45° FOV — 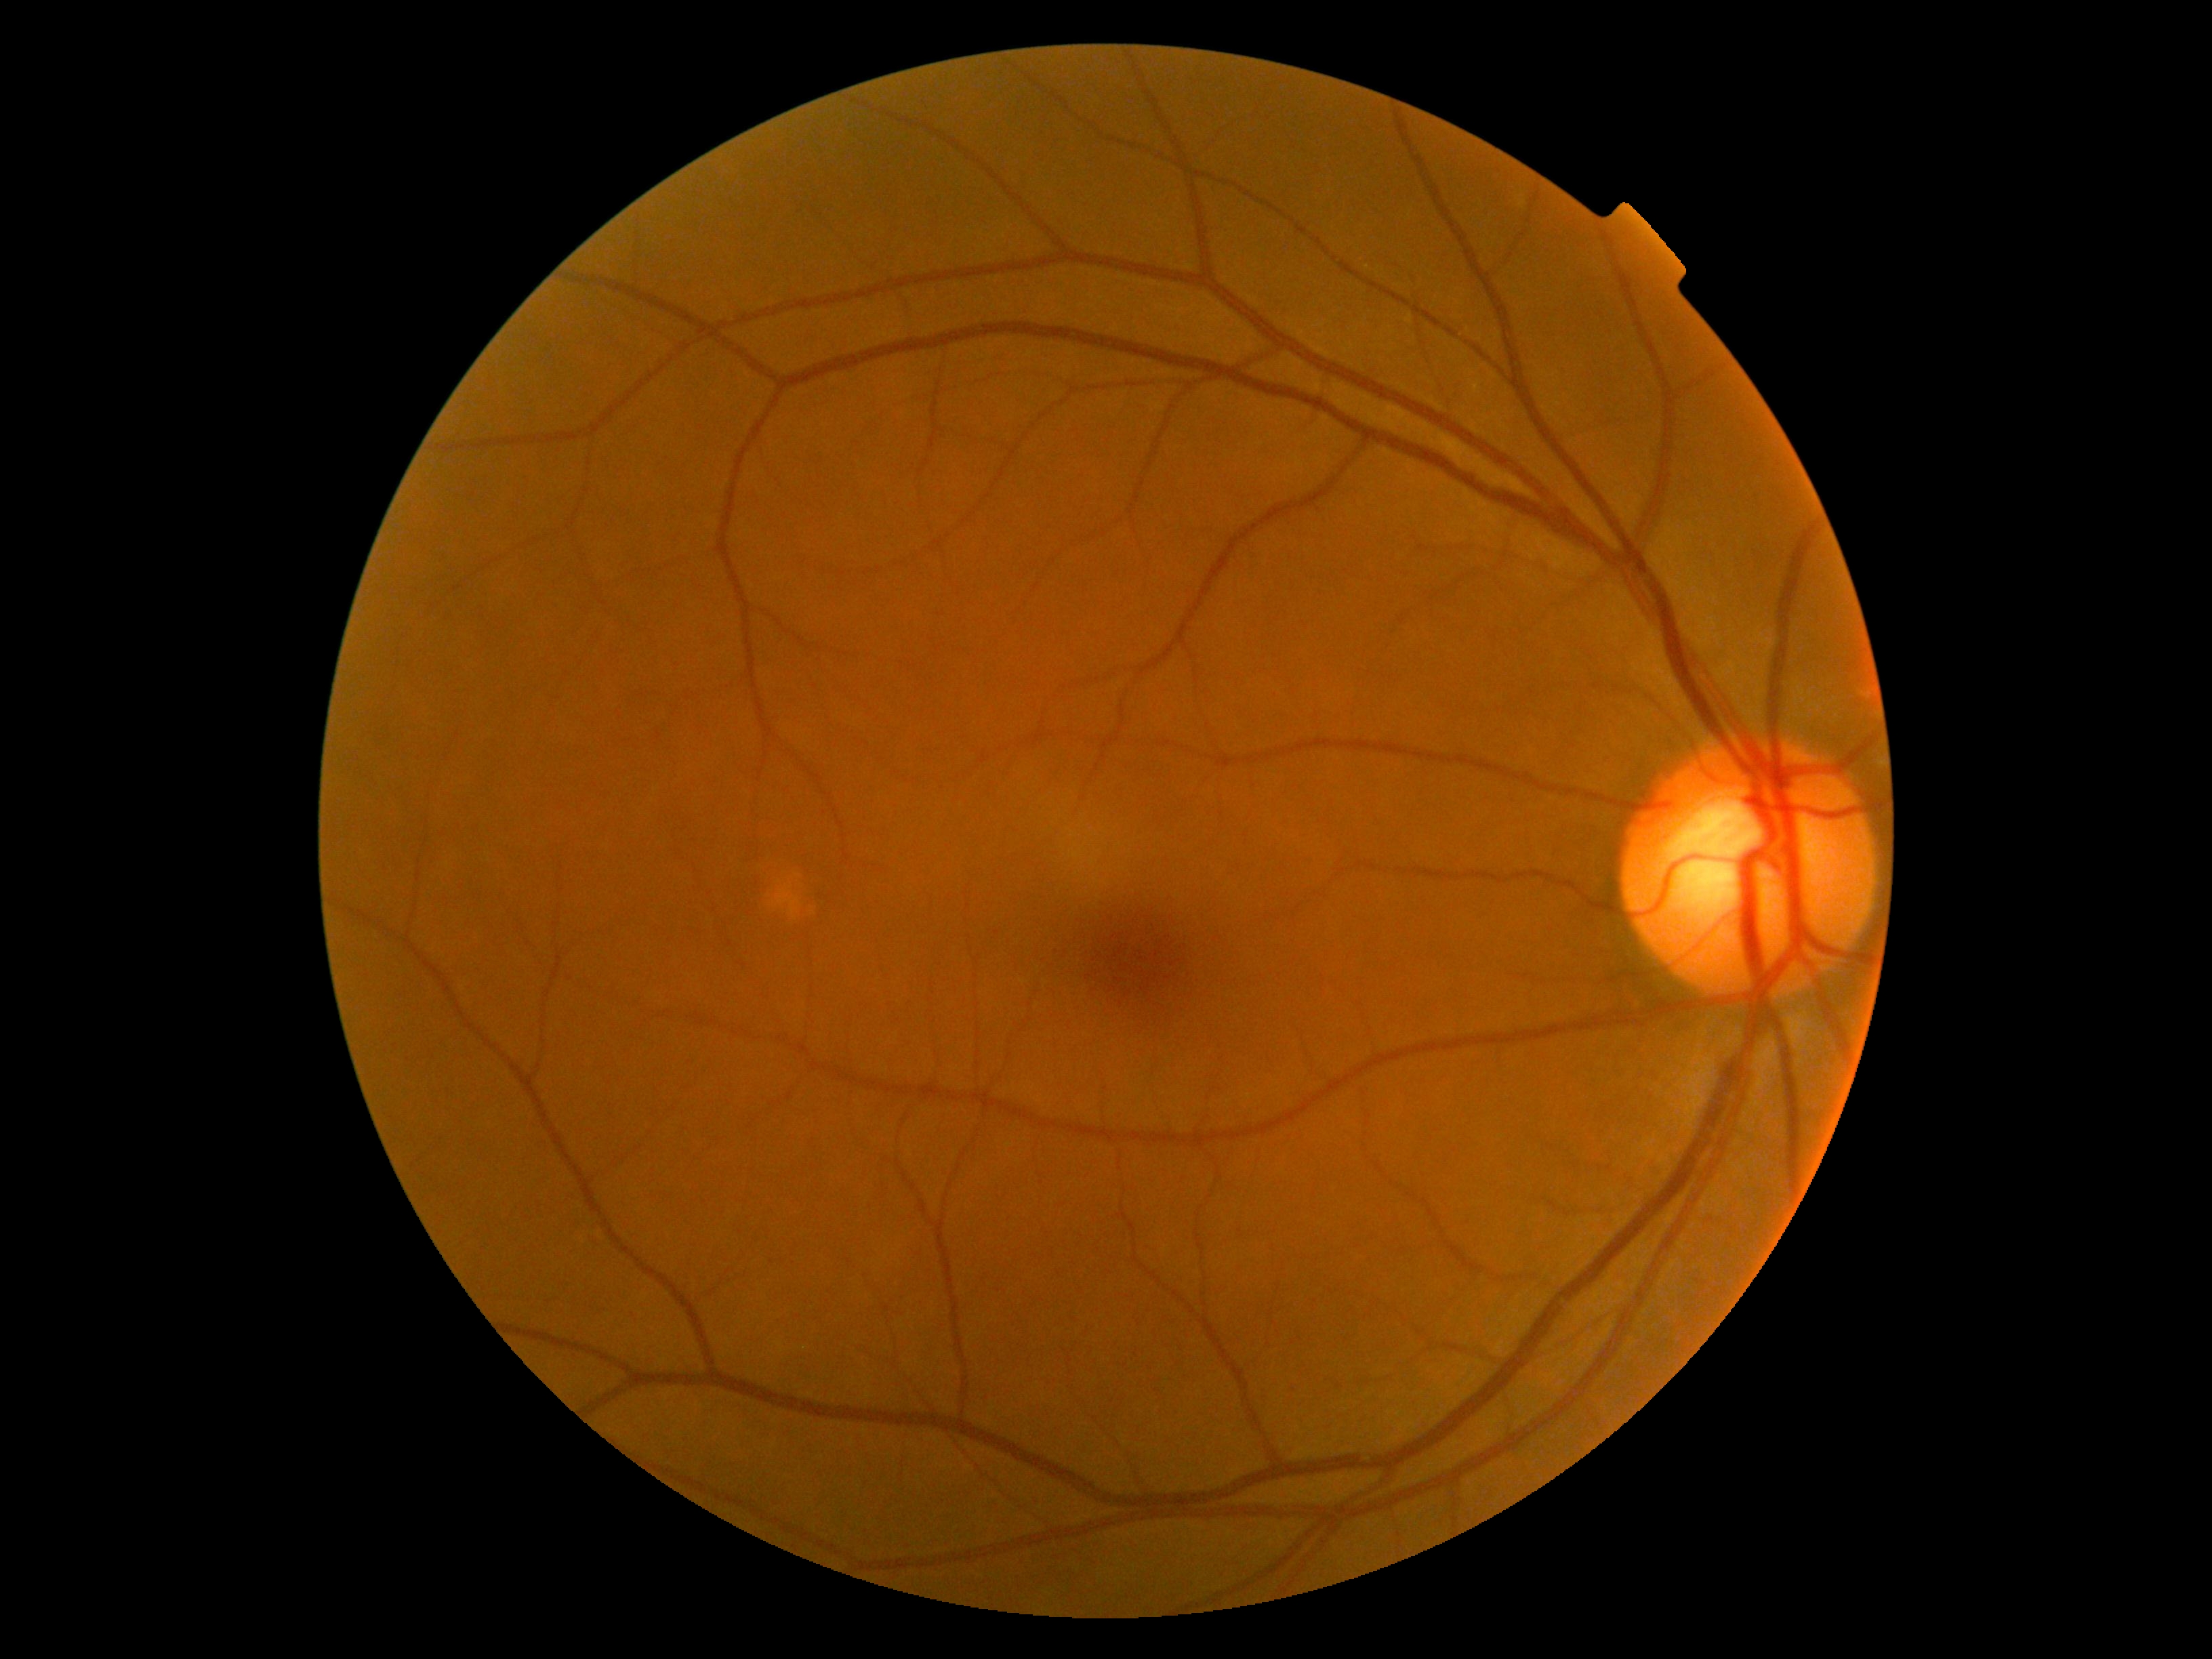

{"dr_grade": "0", "dr_impression": "negative for DR"}